Wide-field fundus image from infant ROP screening.
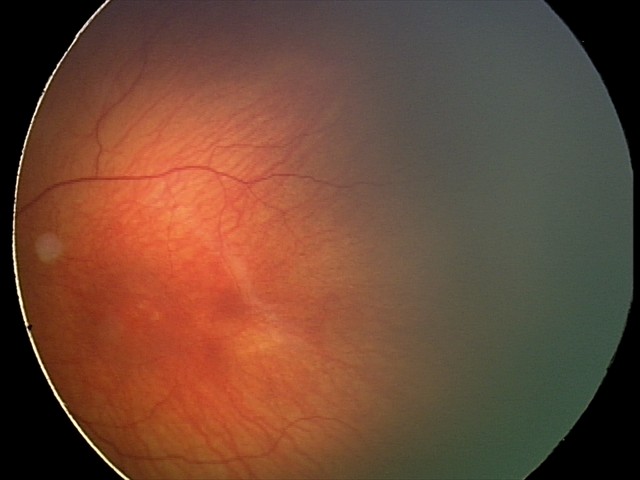

Series diagnosed as status post ROP. No plus disease.